2212x1659 · CFP · 45-degree field of view — 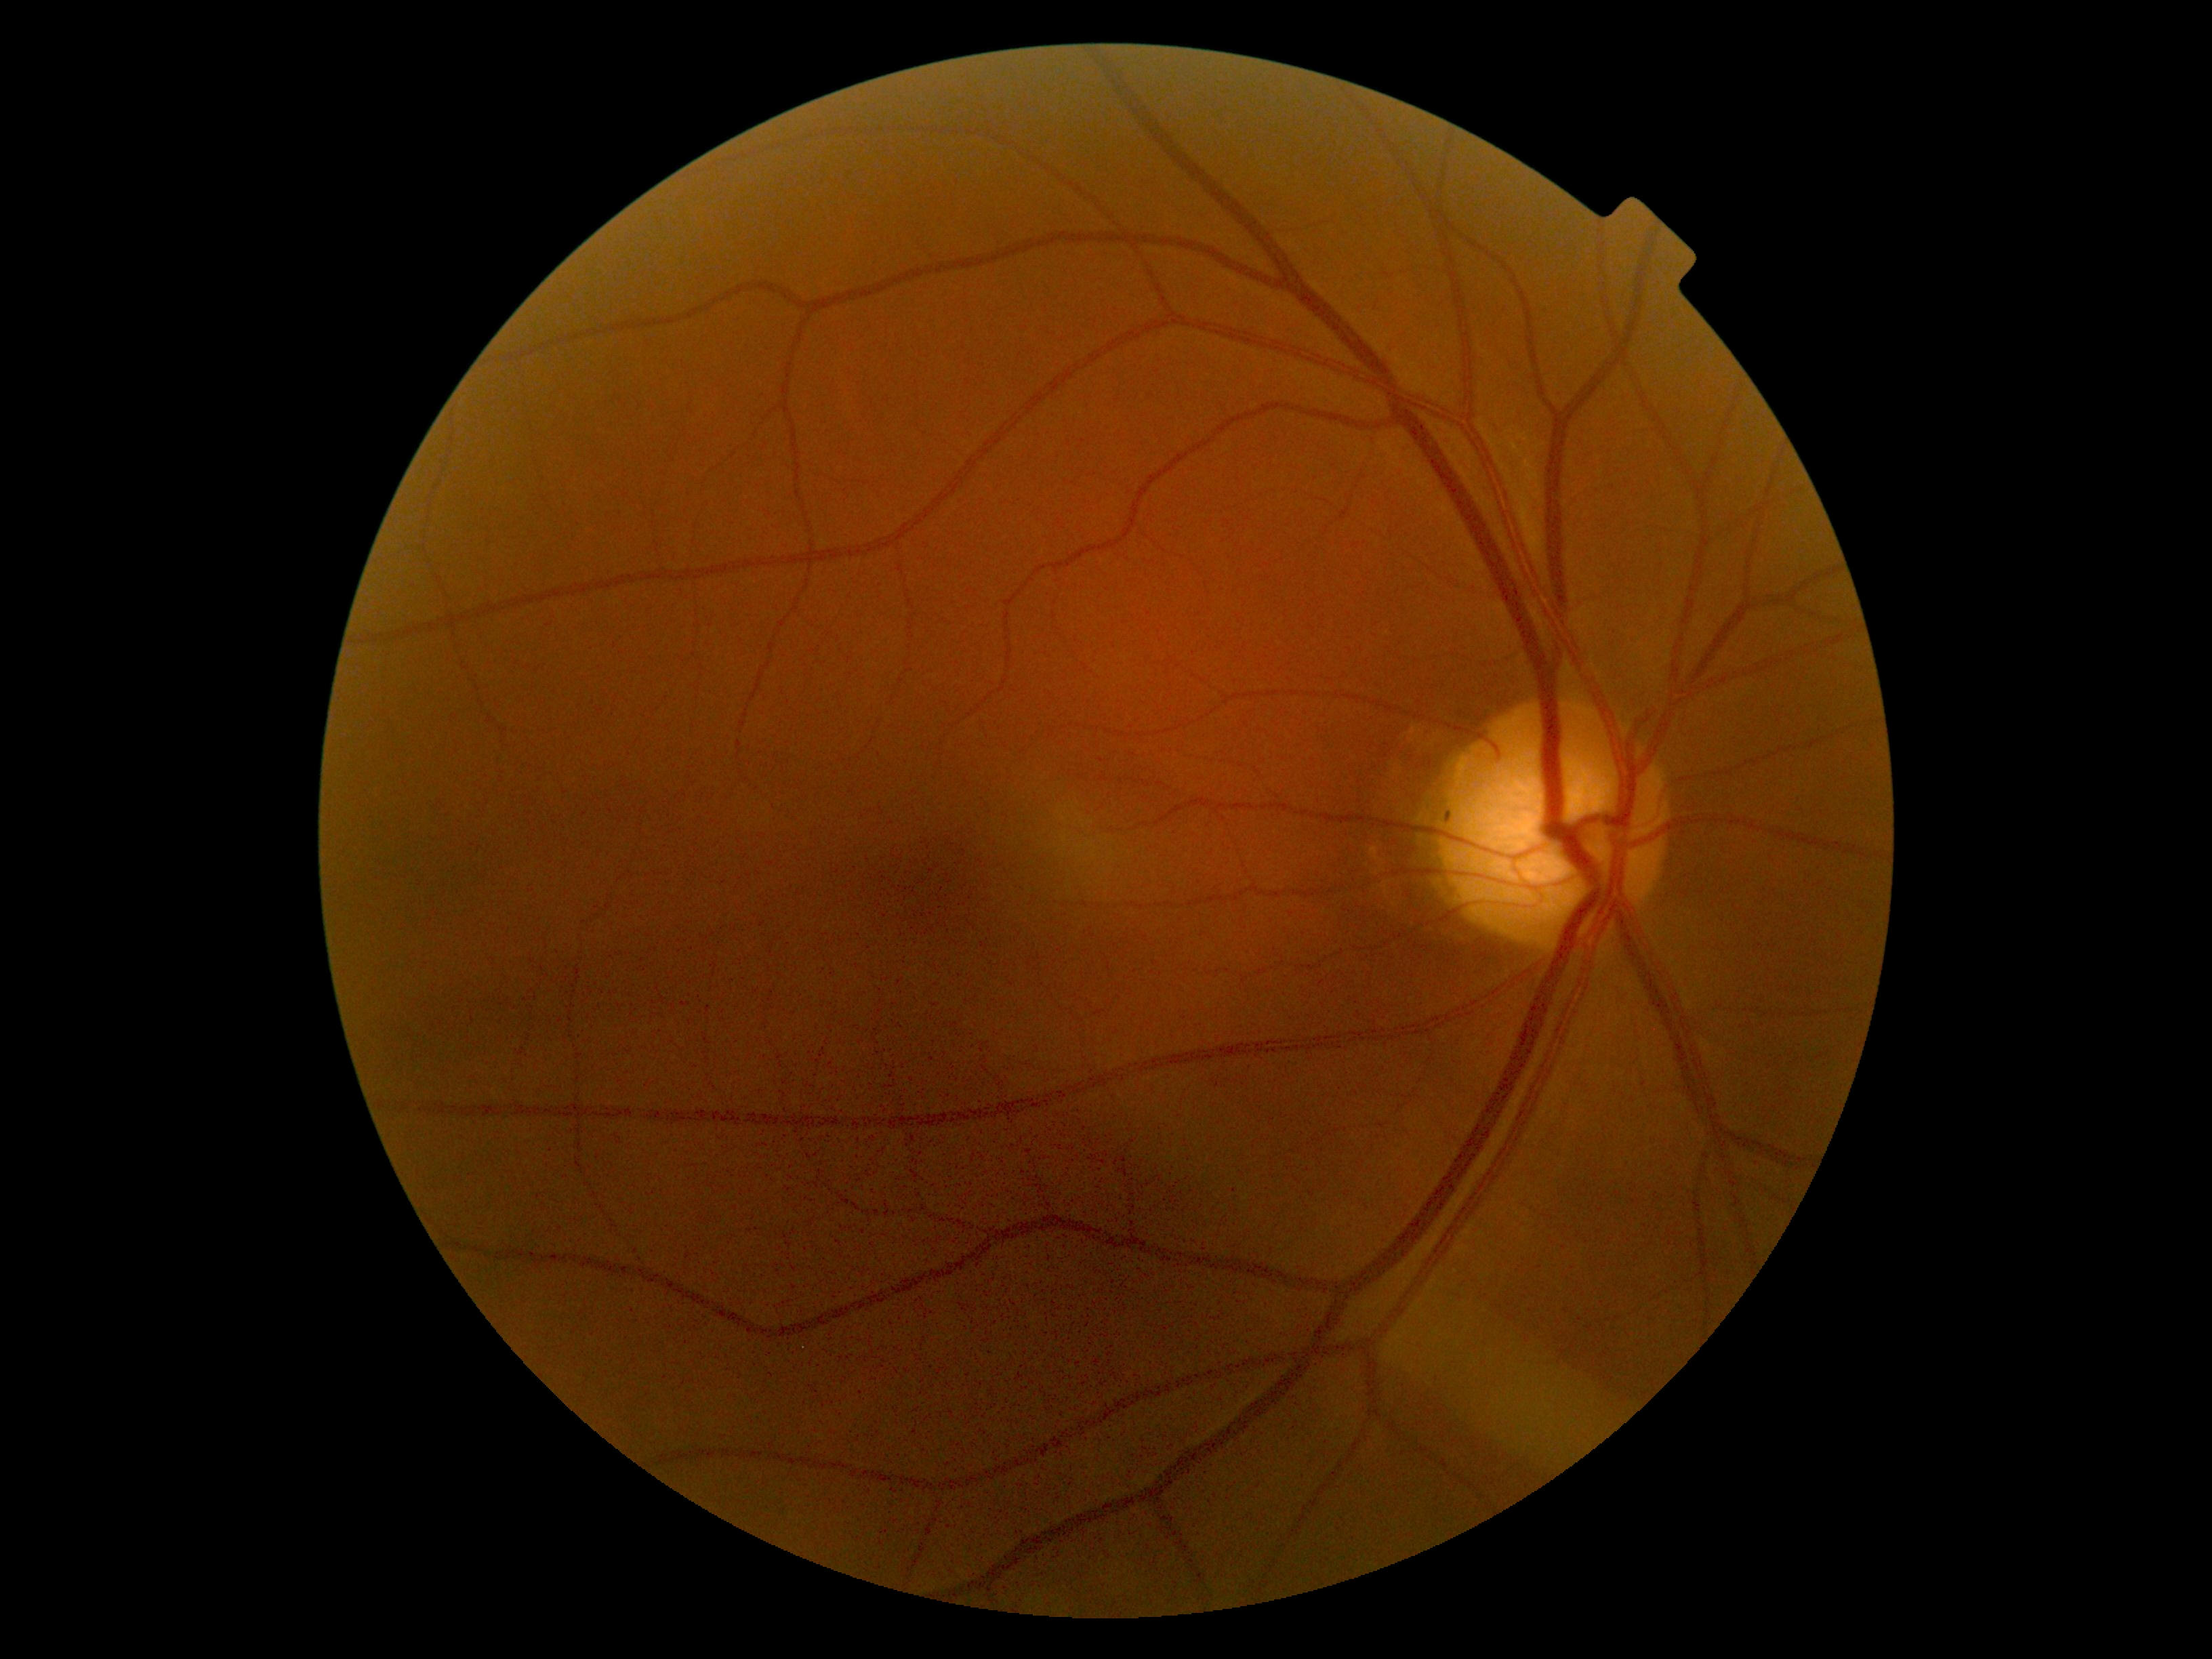

Diabetic retinopathy (DR): grade 0.